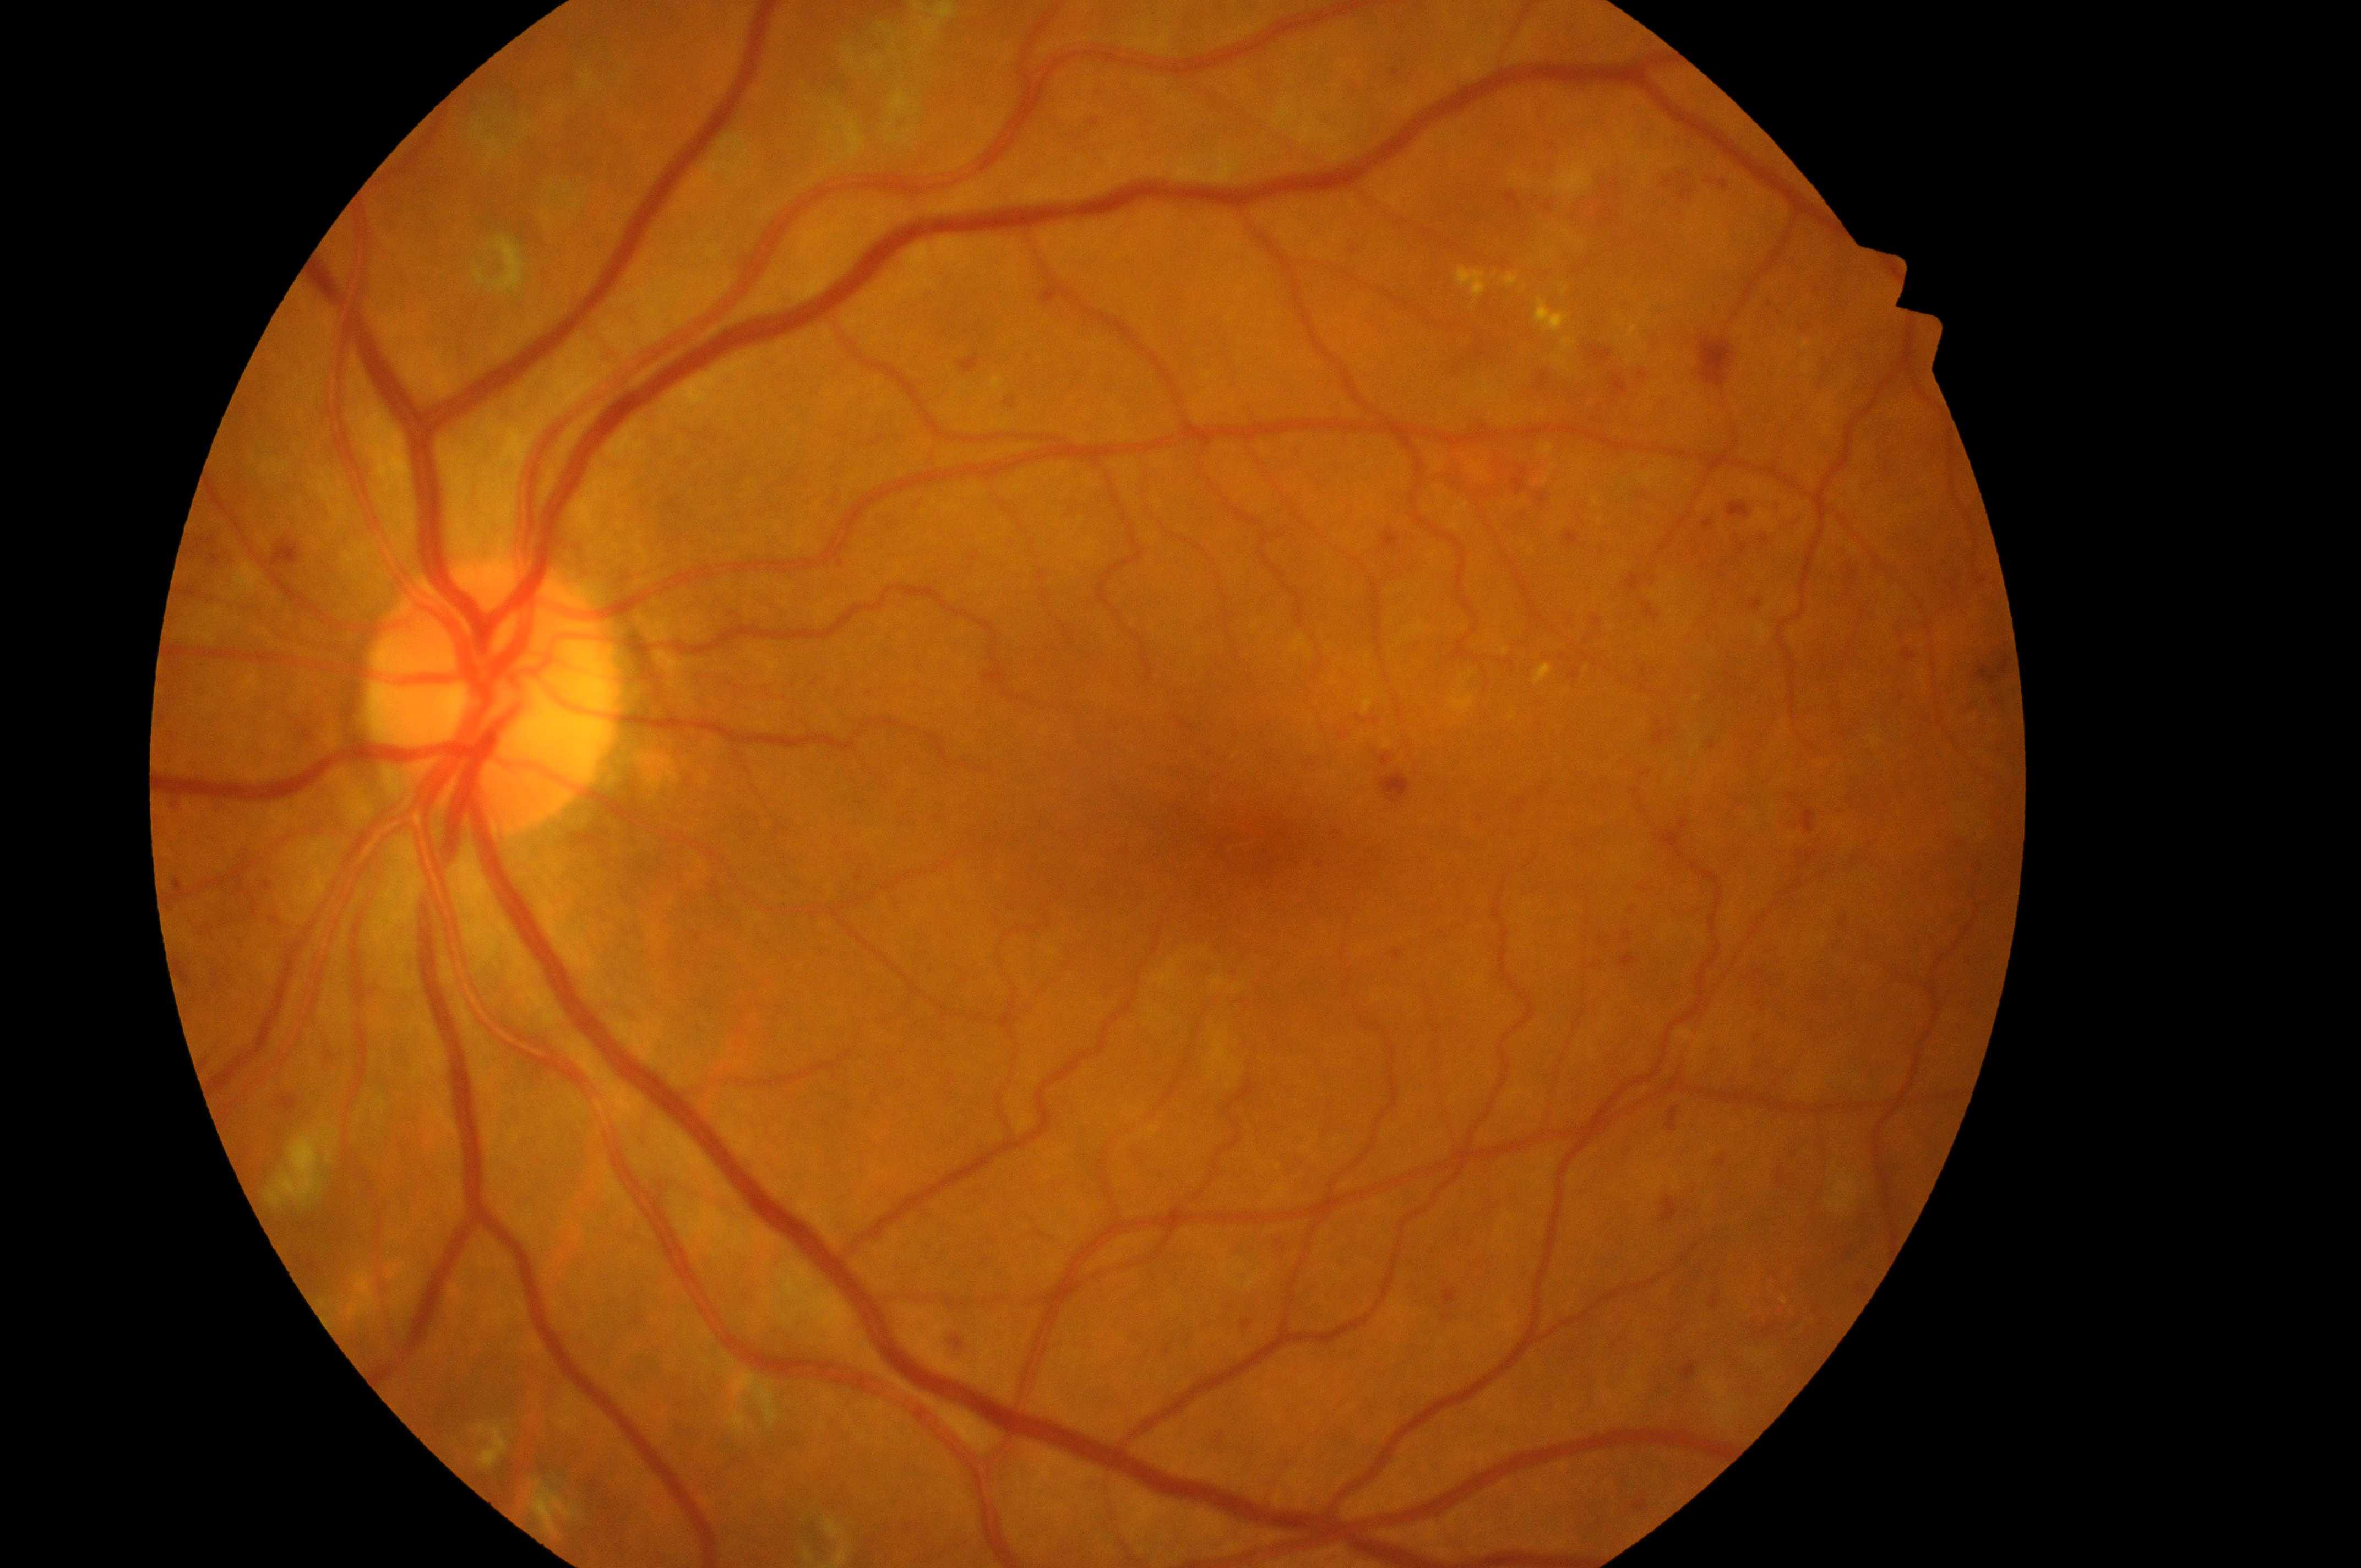 Optic nerve head located at x=488, y=703. Risk of diabetic macular edema is 2/2. Eye: left eye. The fovea centralis is at x=1271, y=845. The retinopathy is classified as non-proliferative diabetic retinopathy. Retinopathy: 3/4.